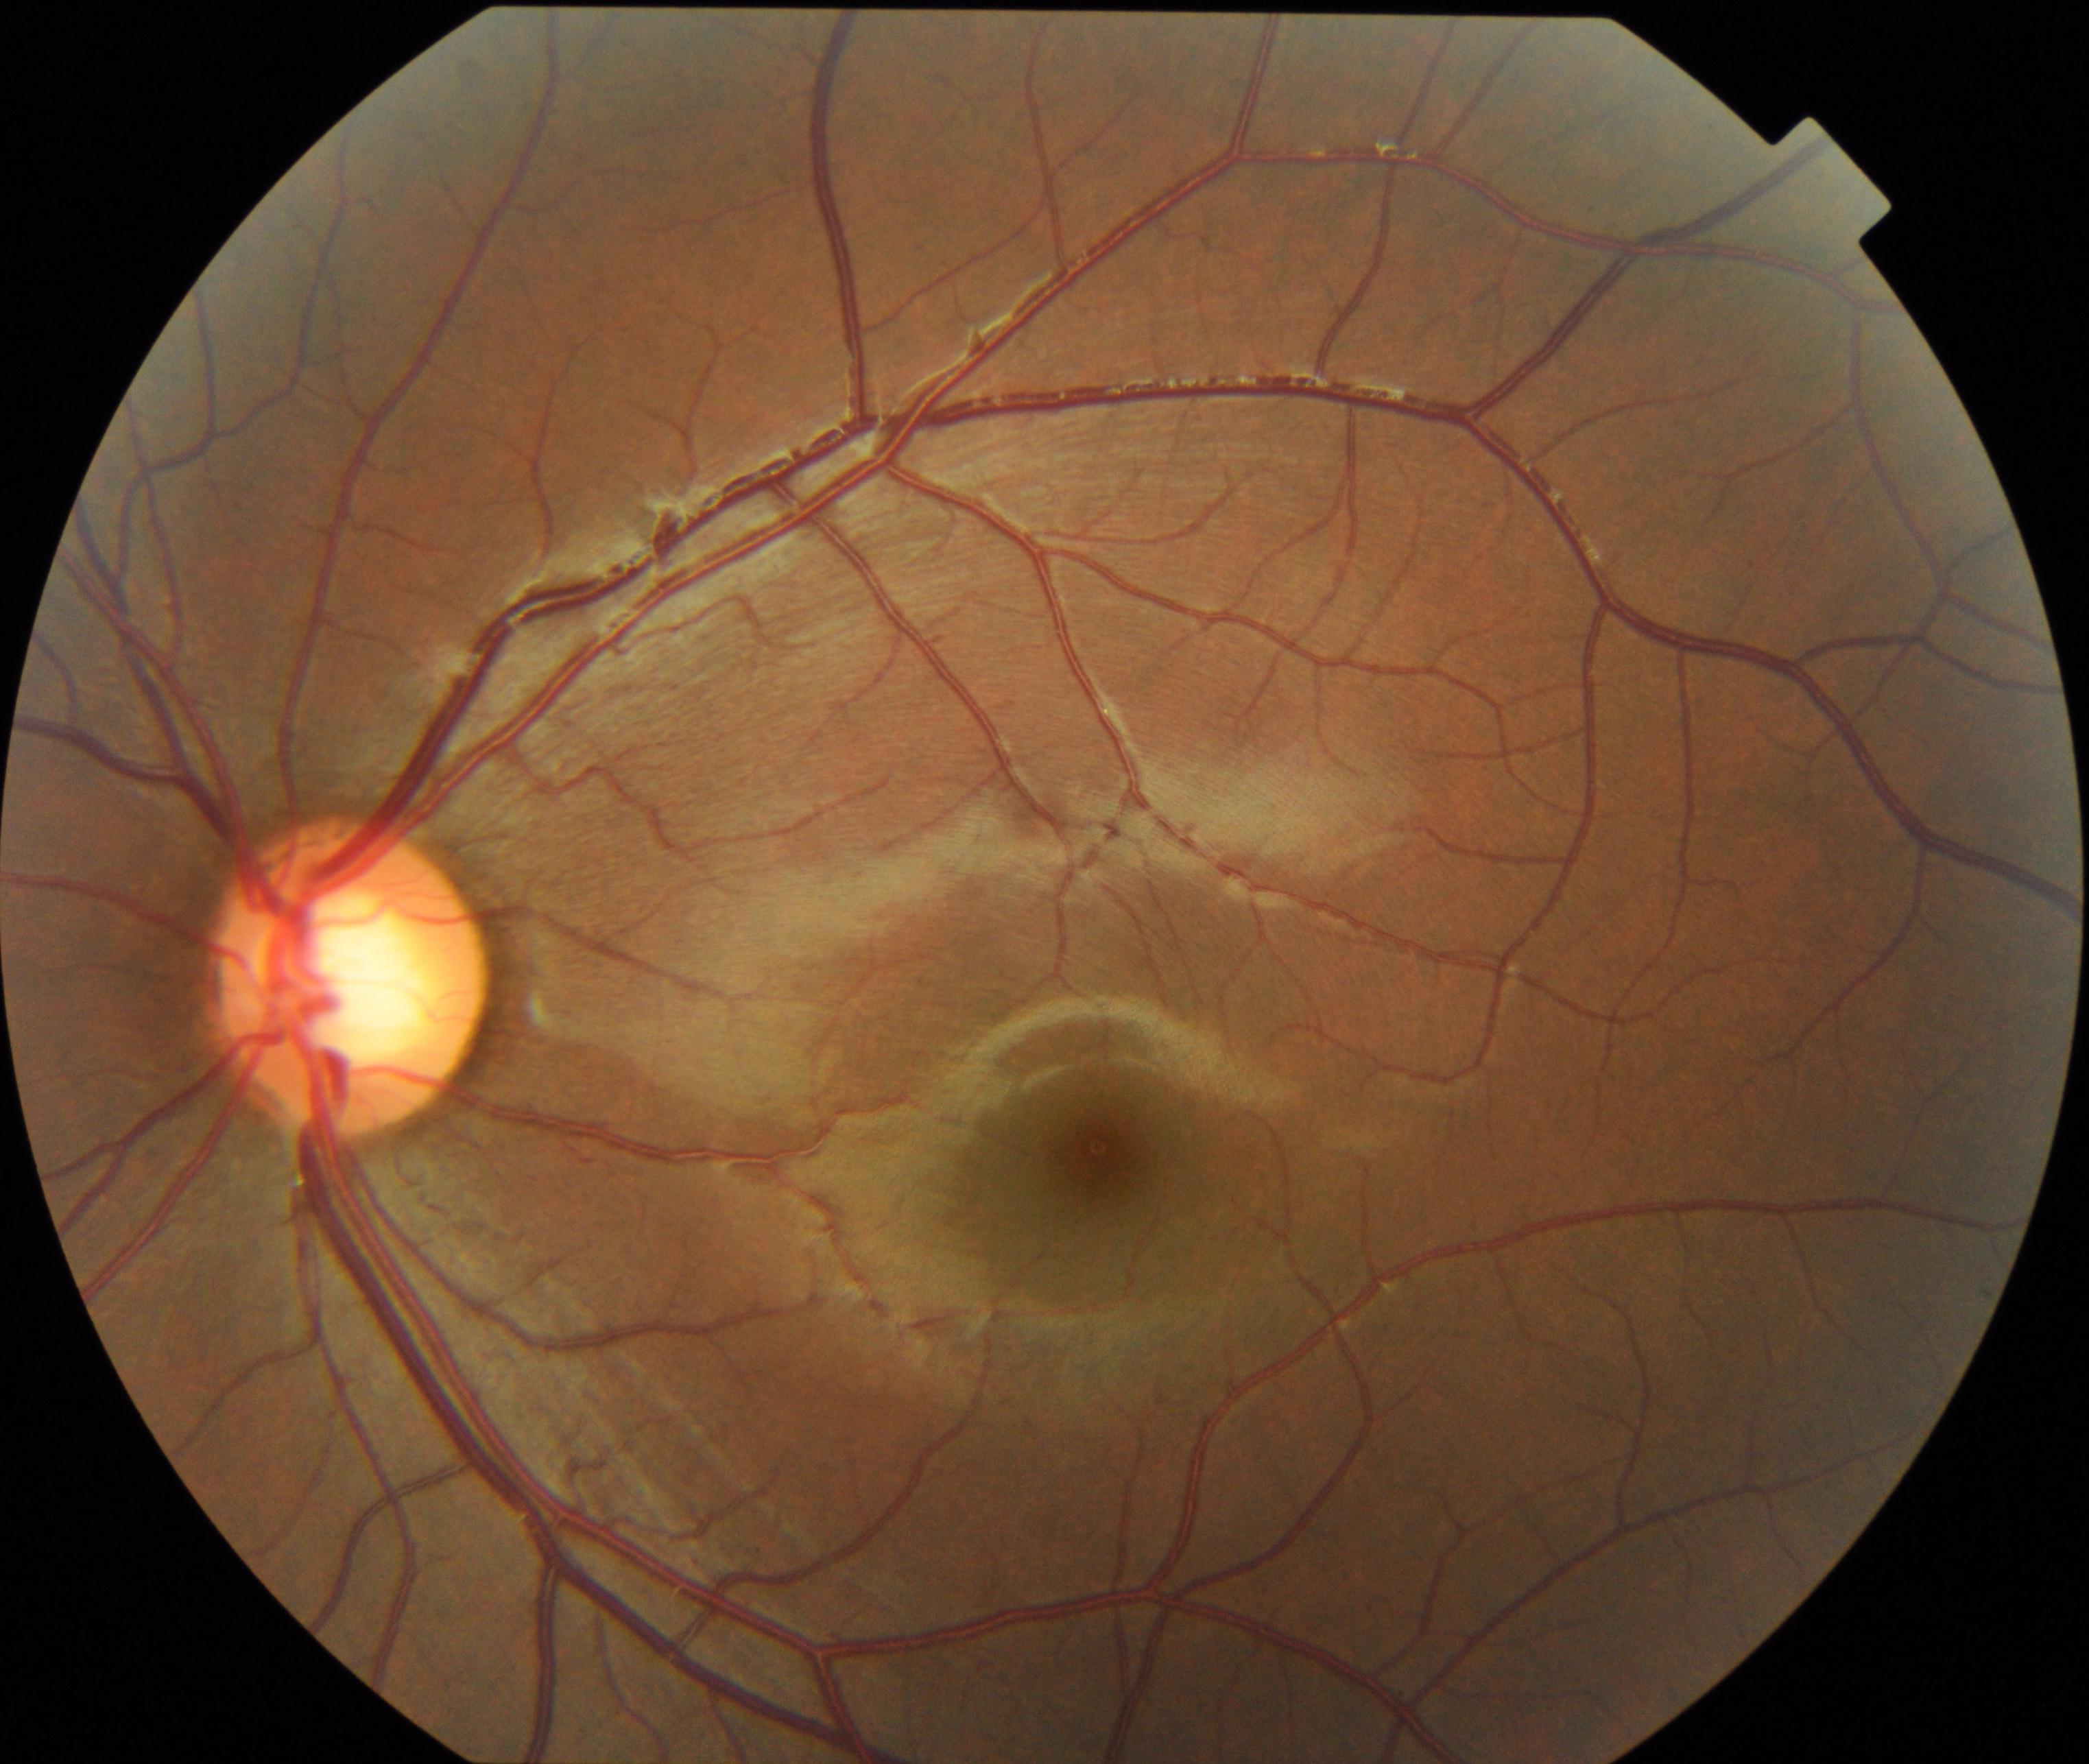
Classification: large optic cup.